Pediatric retinal photograph (wide-field): 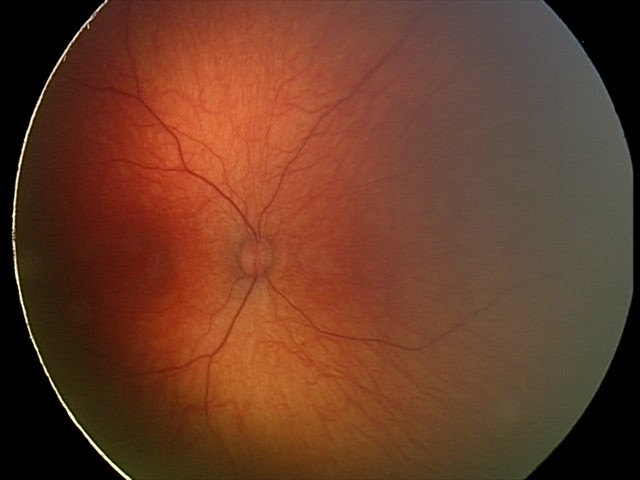
Normal screening examination.